45-degree field of view:
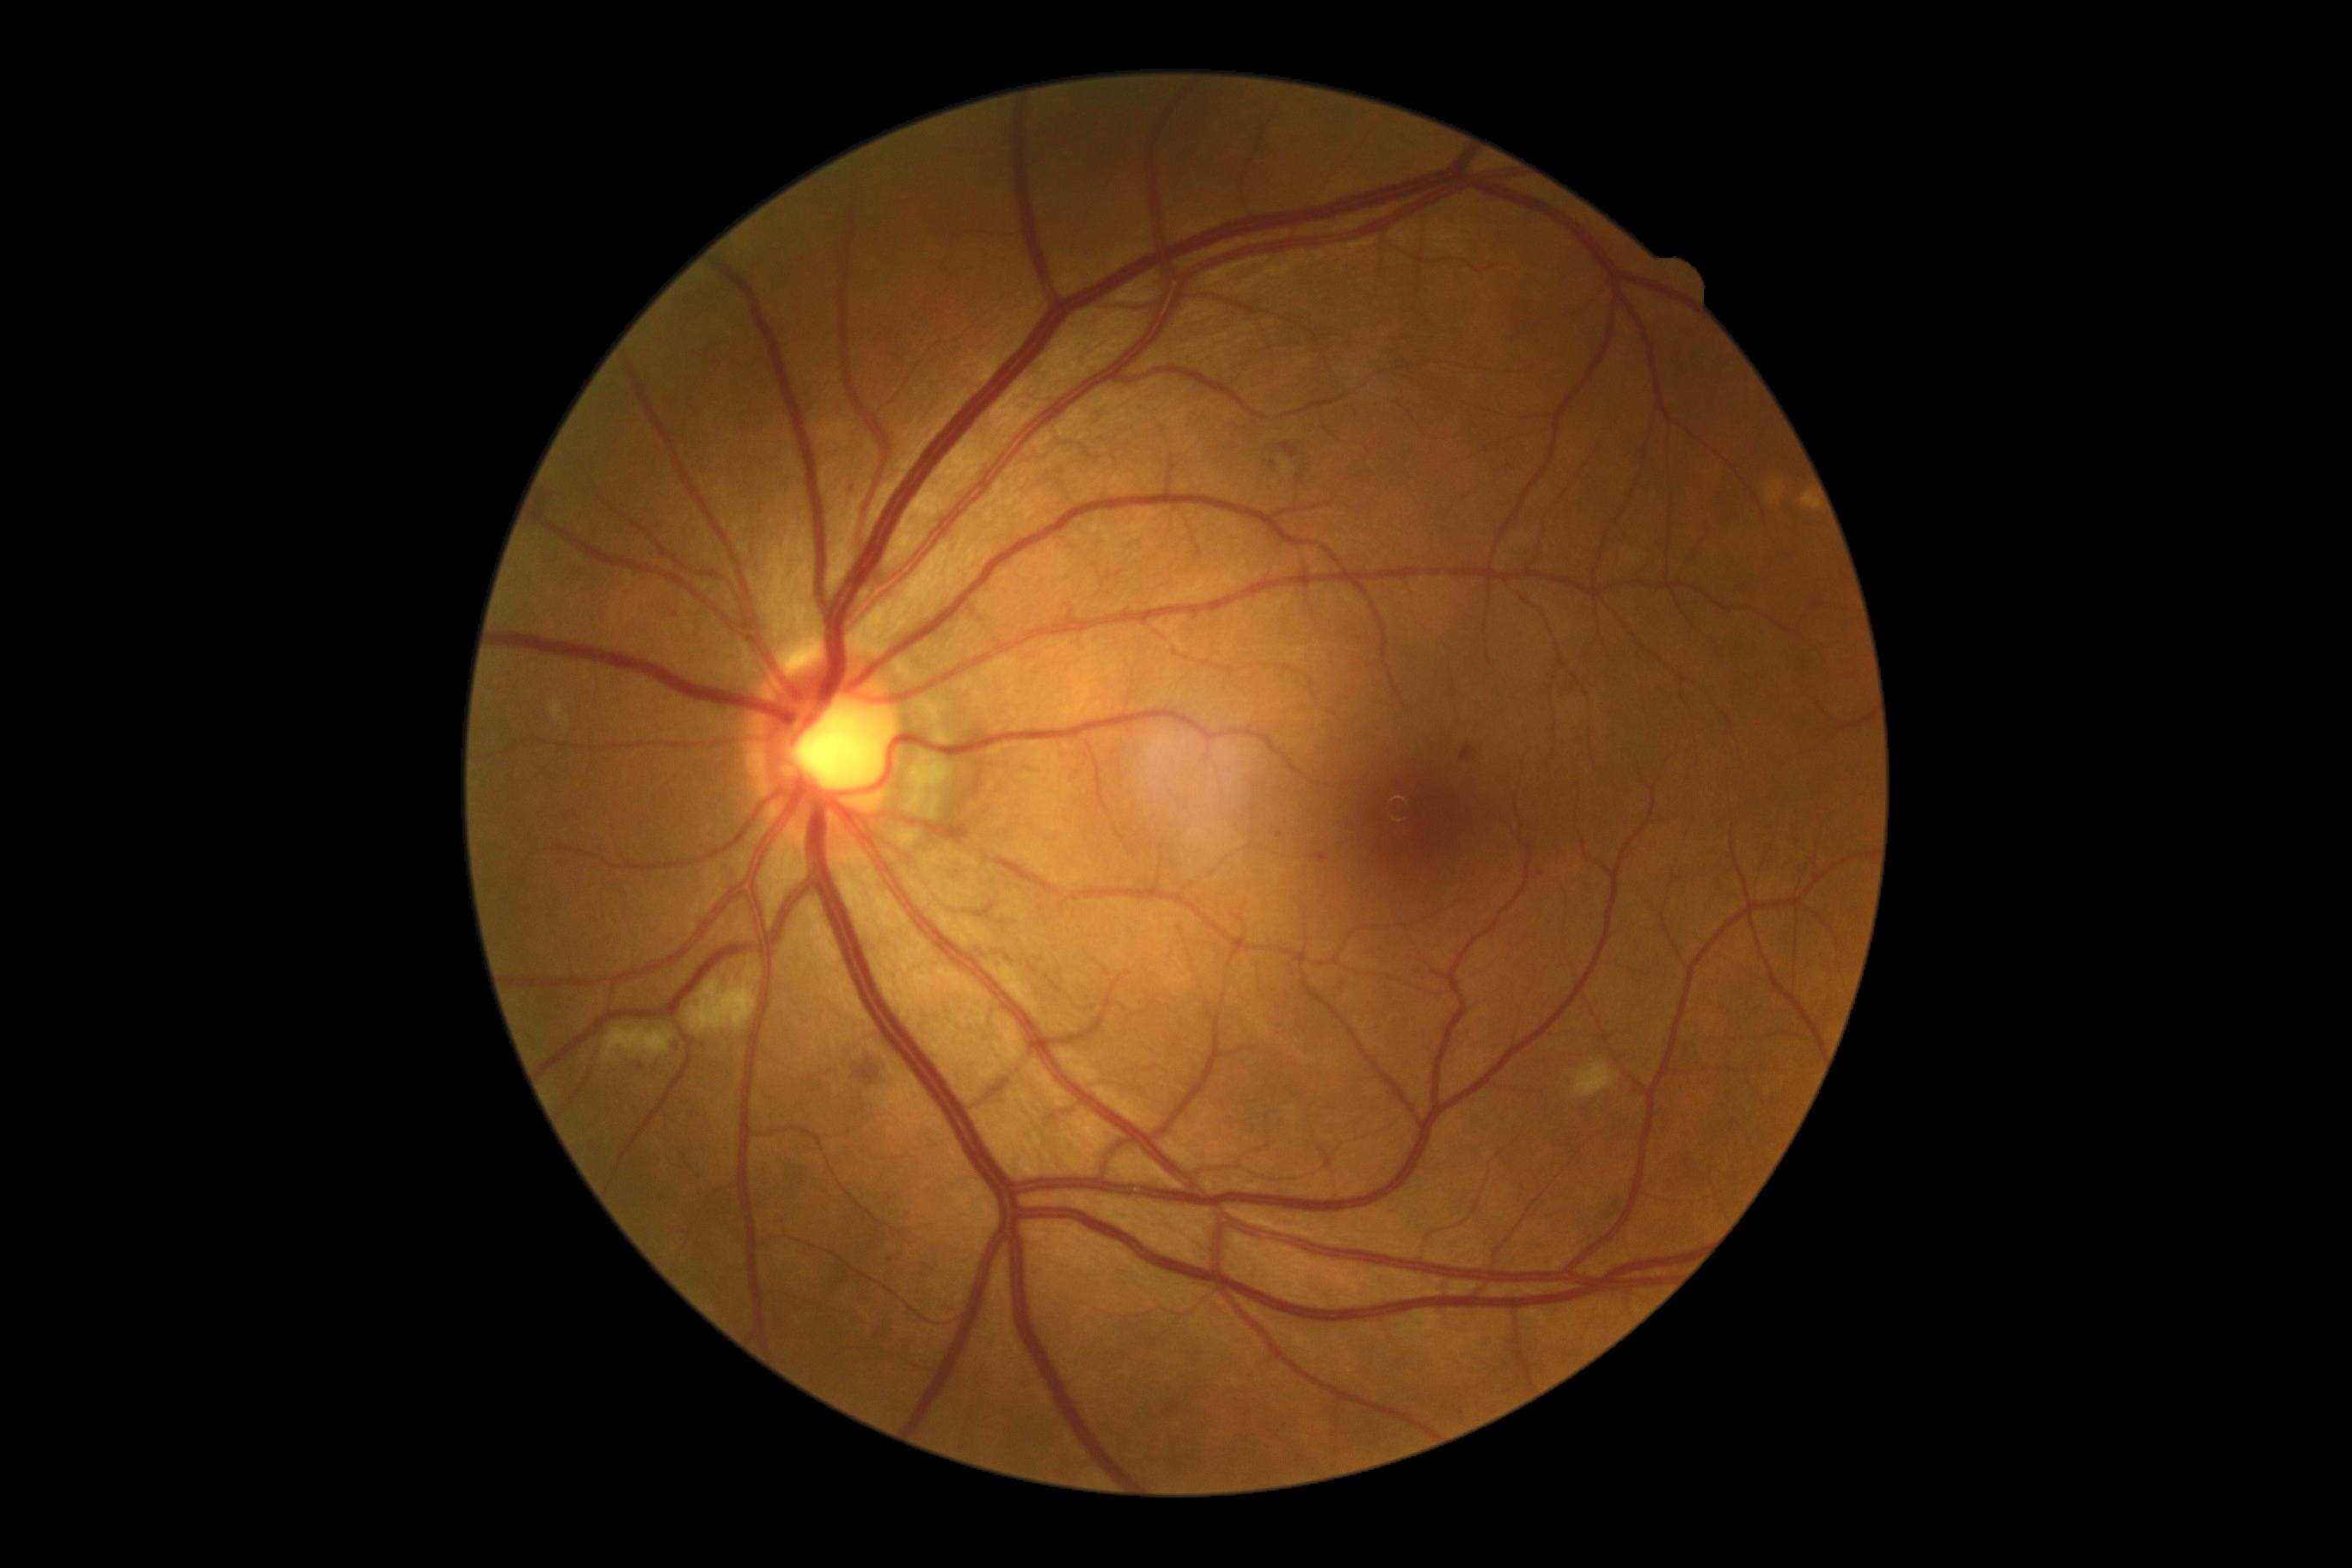 Diabetic retinopathy severity is grade 2.